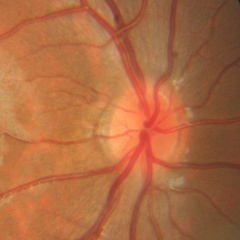 No glaucomatous changes.